Infant wide-field fundus photograph. 640 by 480 pixels: 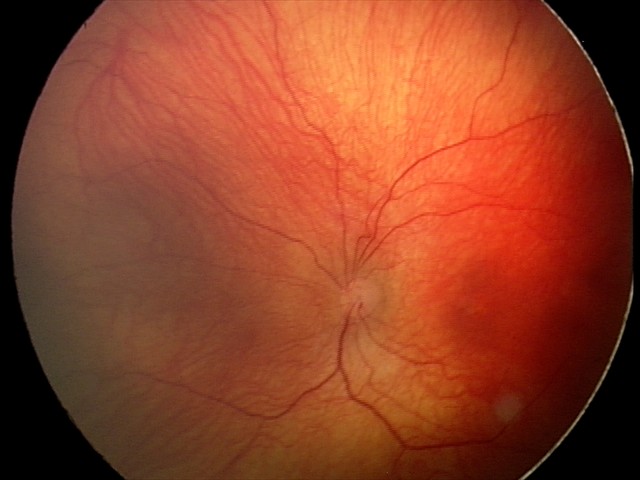
No plus disease.
Examination diagnosed as status post retinopathy of prematurity.